Davis DR grading: 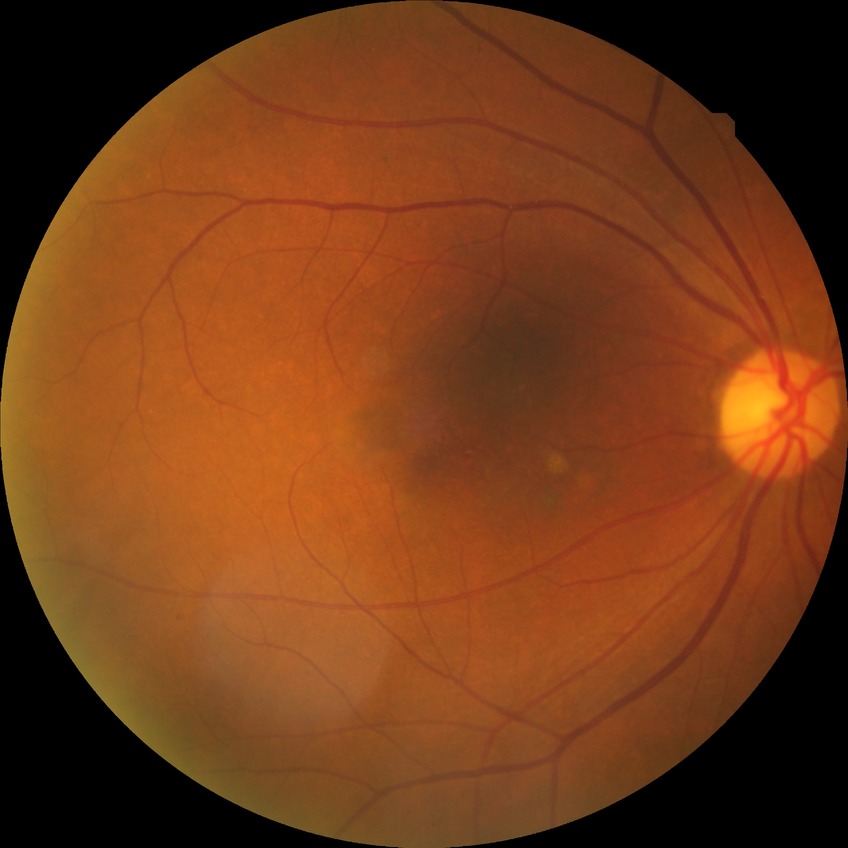
Diabetic retinopathy (DR): no diabetic retinopathy (NDR).